Acquired with a Nidek AFC-330 · non-mydriatic fundus camera — 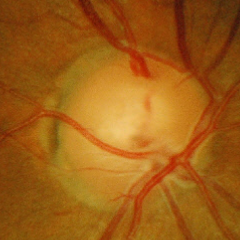

Impression = no signs of glaucoma.